Pediatric wide-field fundus photograph; 640x480px — 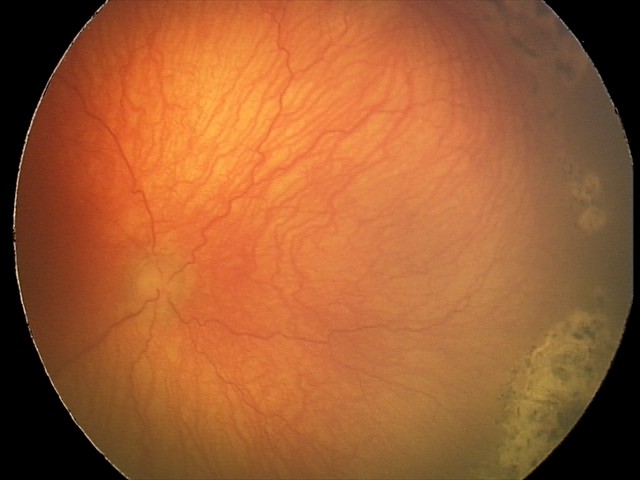
With plus disease. Diagnosis from this screening exam: aggressive retinopathy of prematurity (A-ROP).